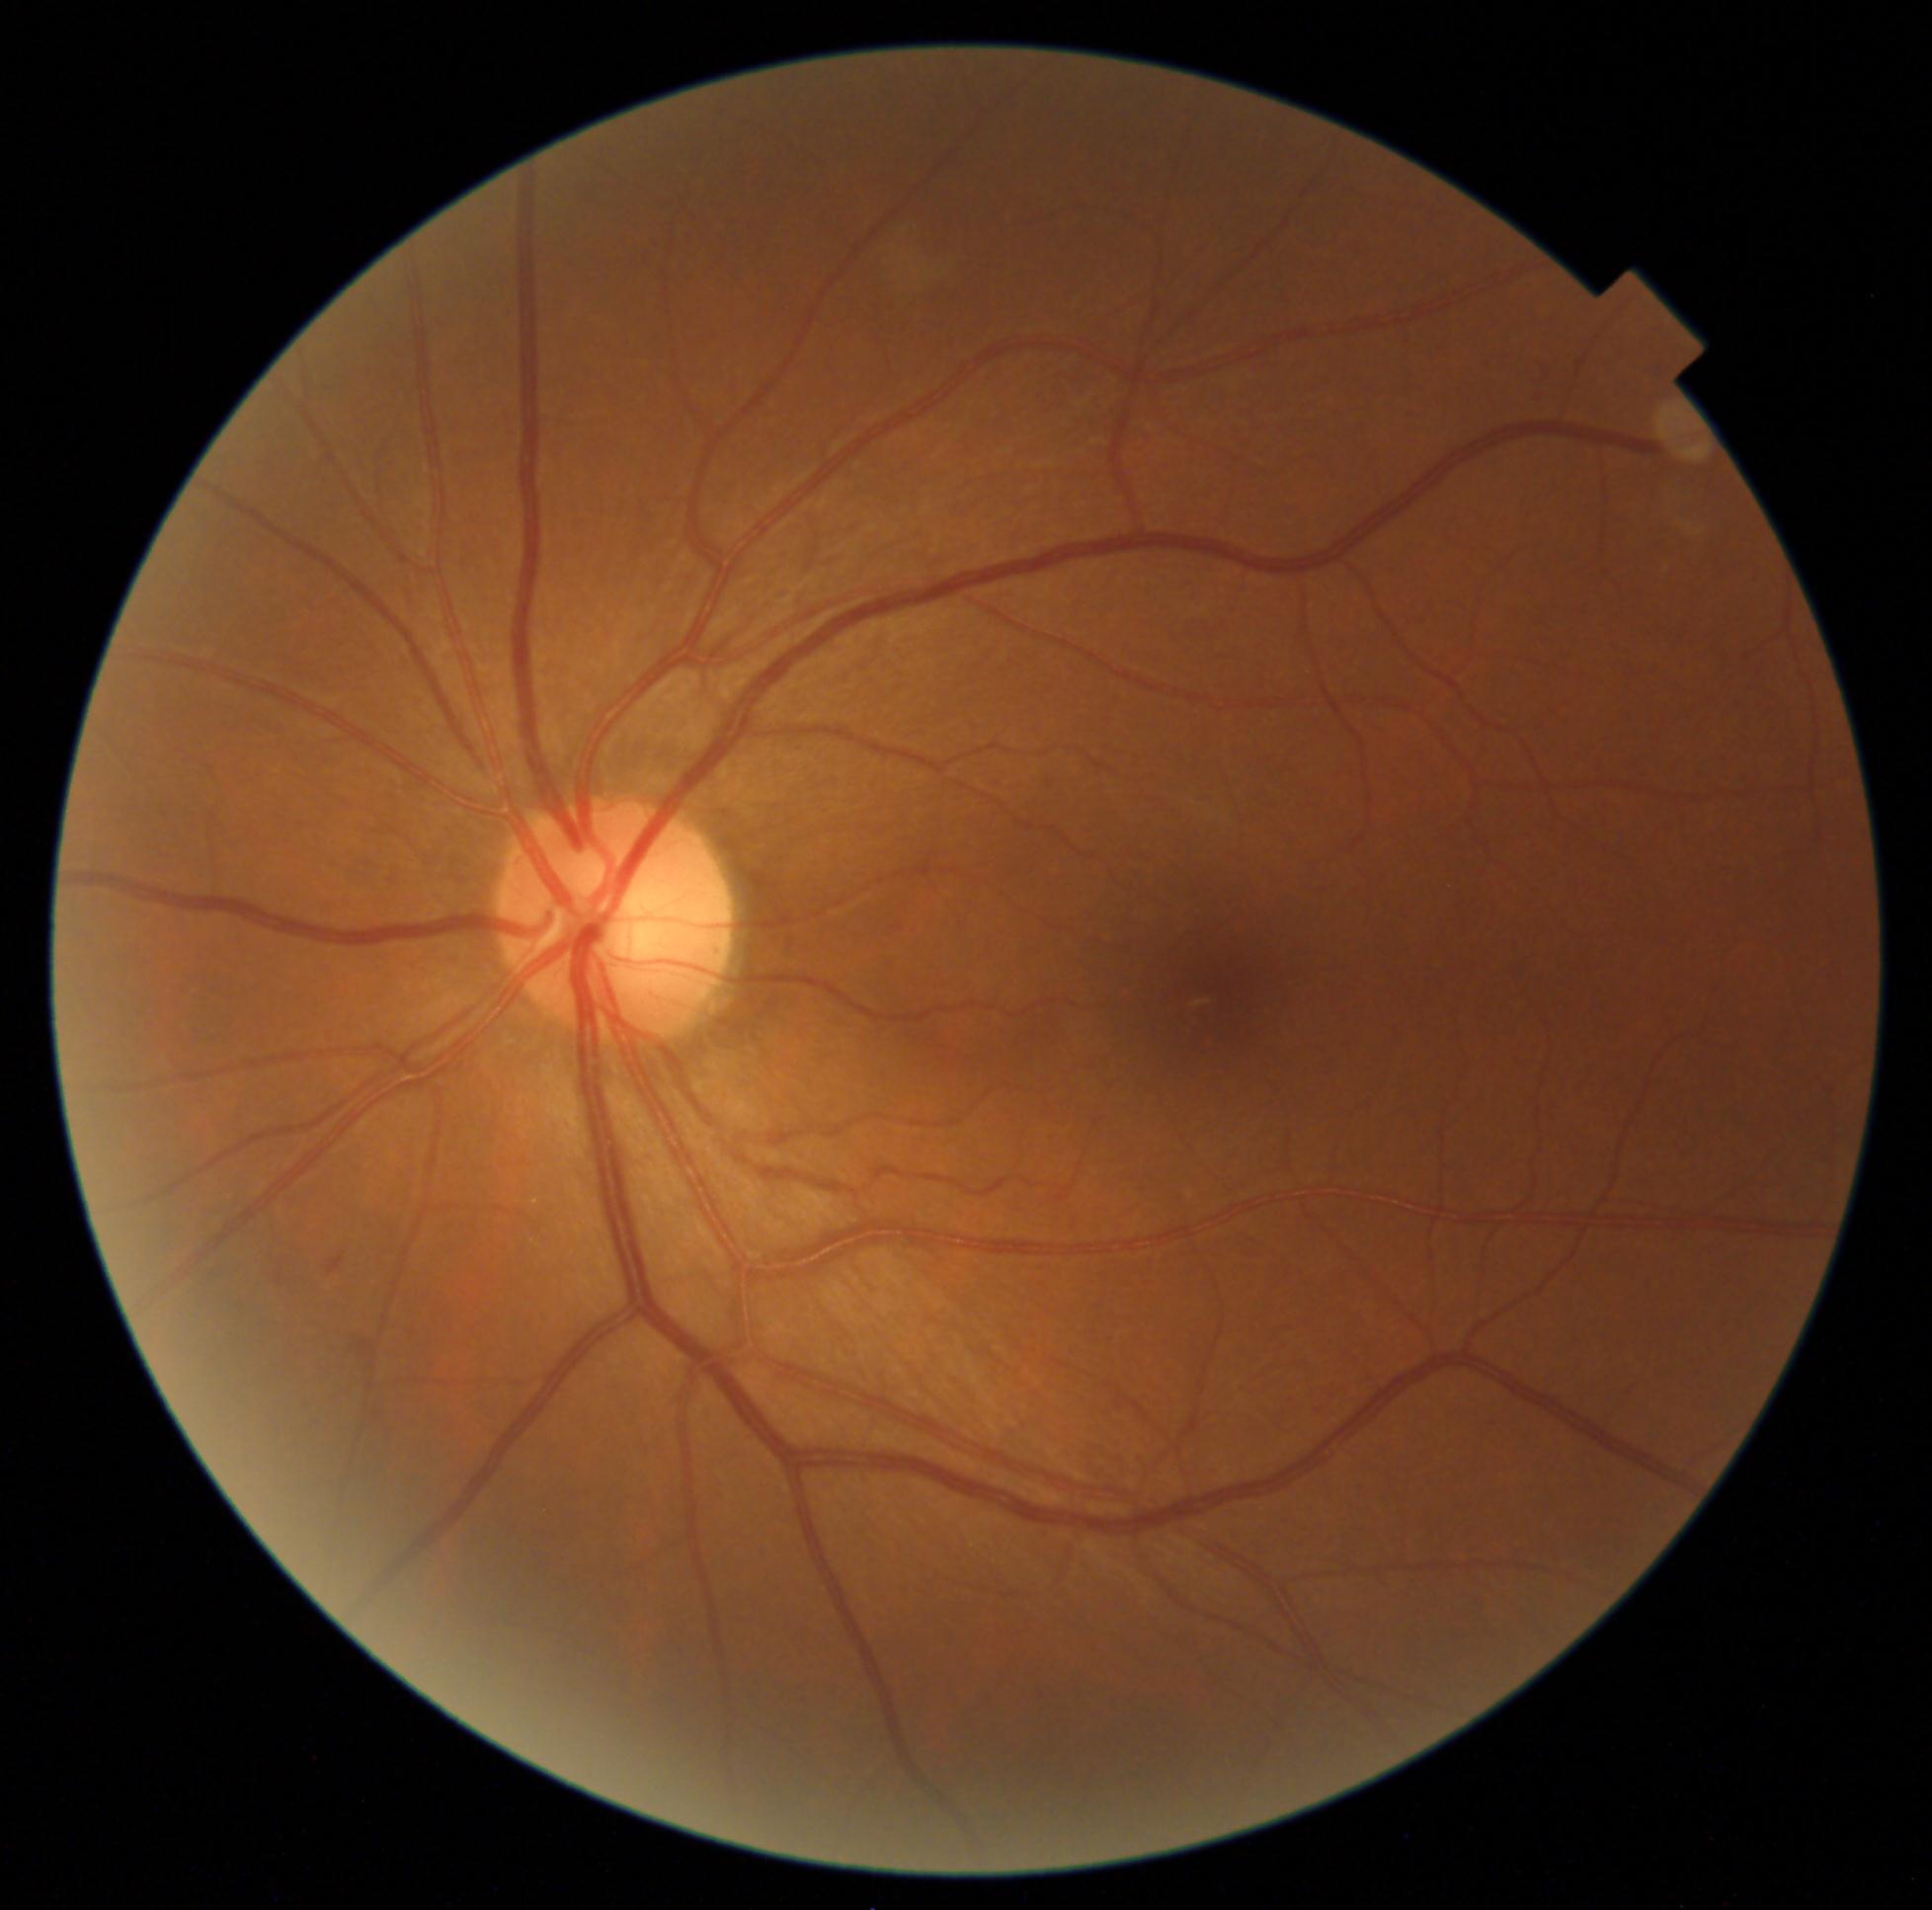

Diabetic retinopathy: grade 2.